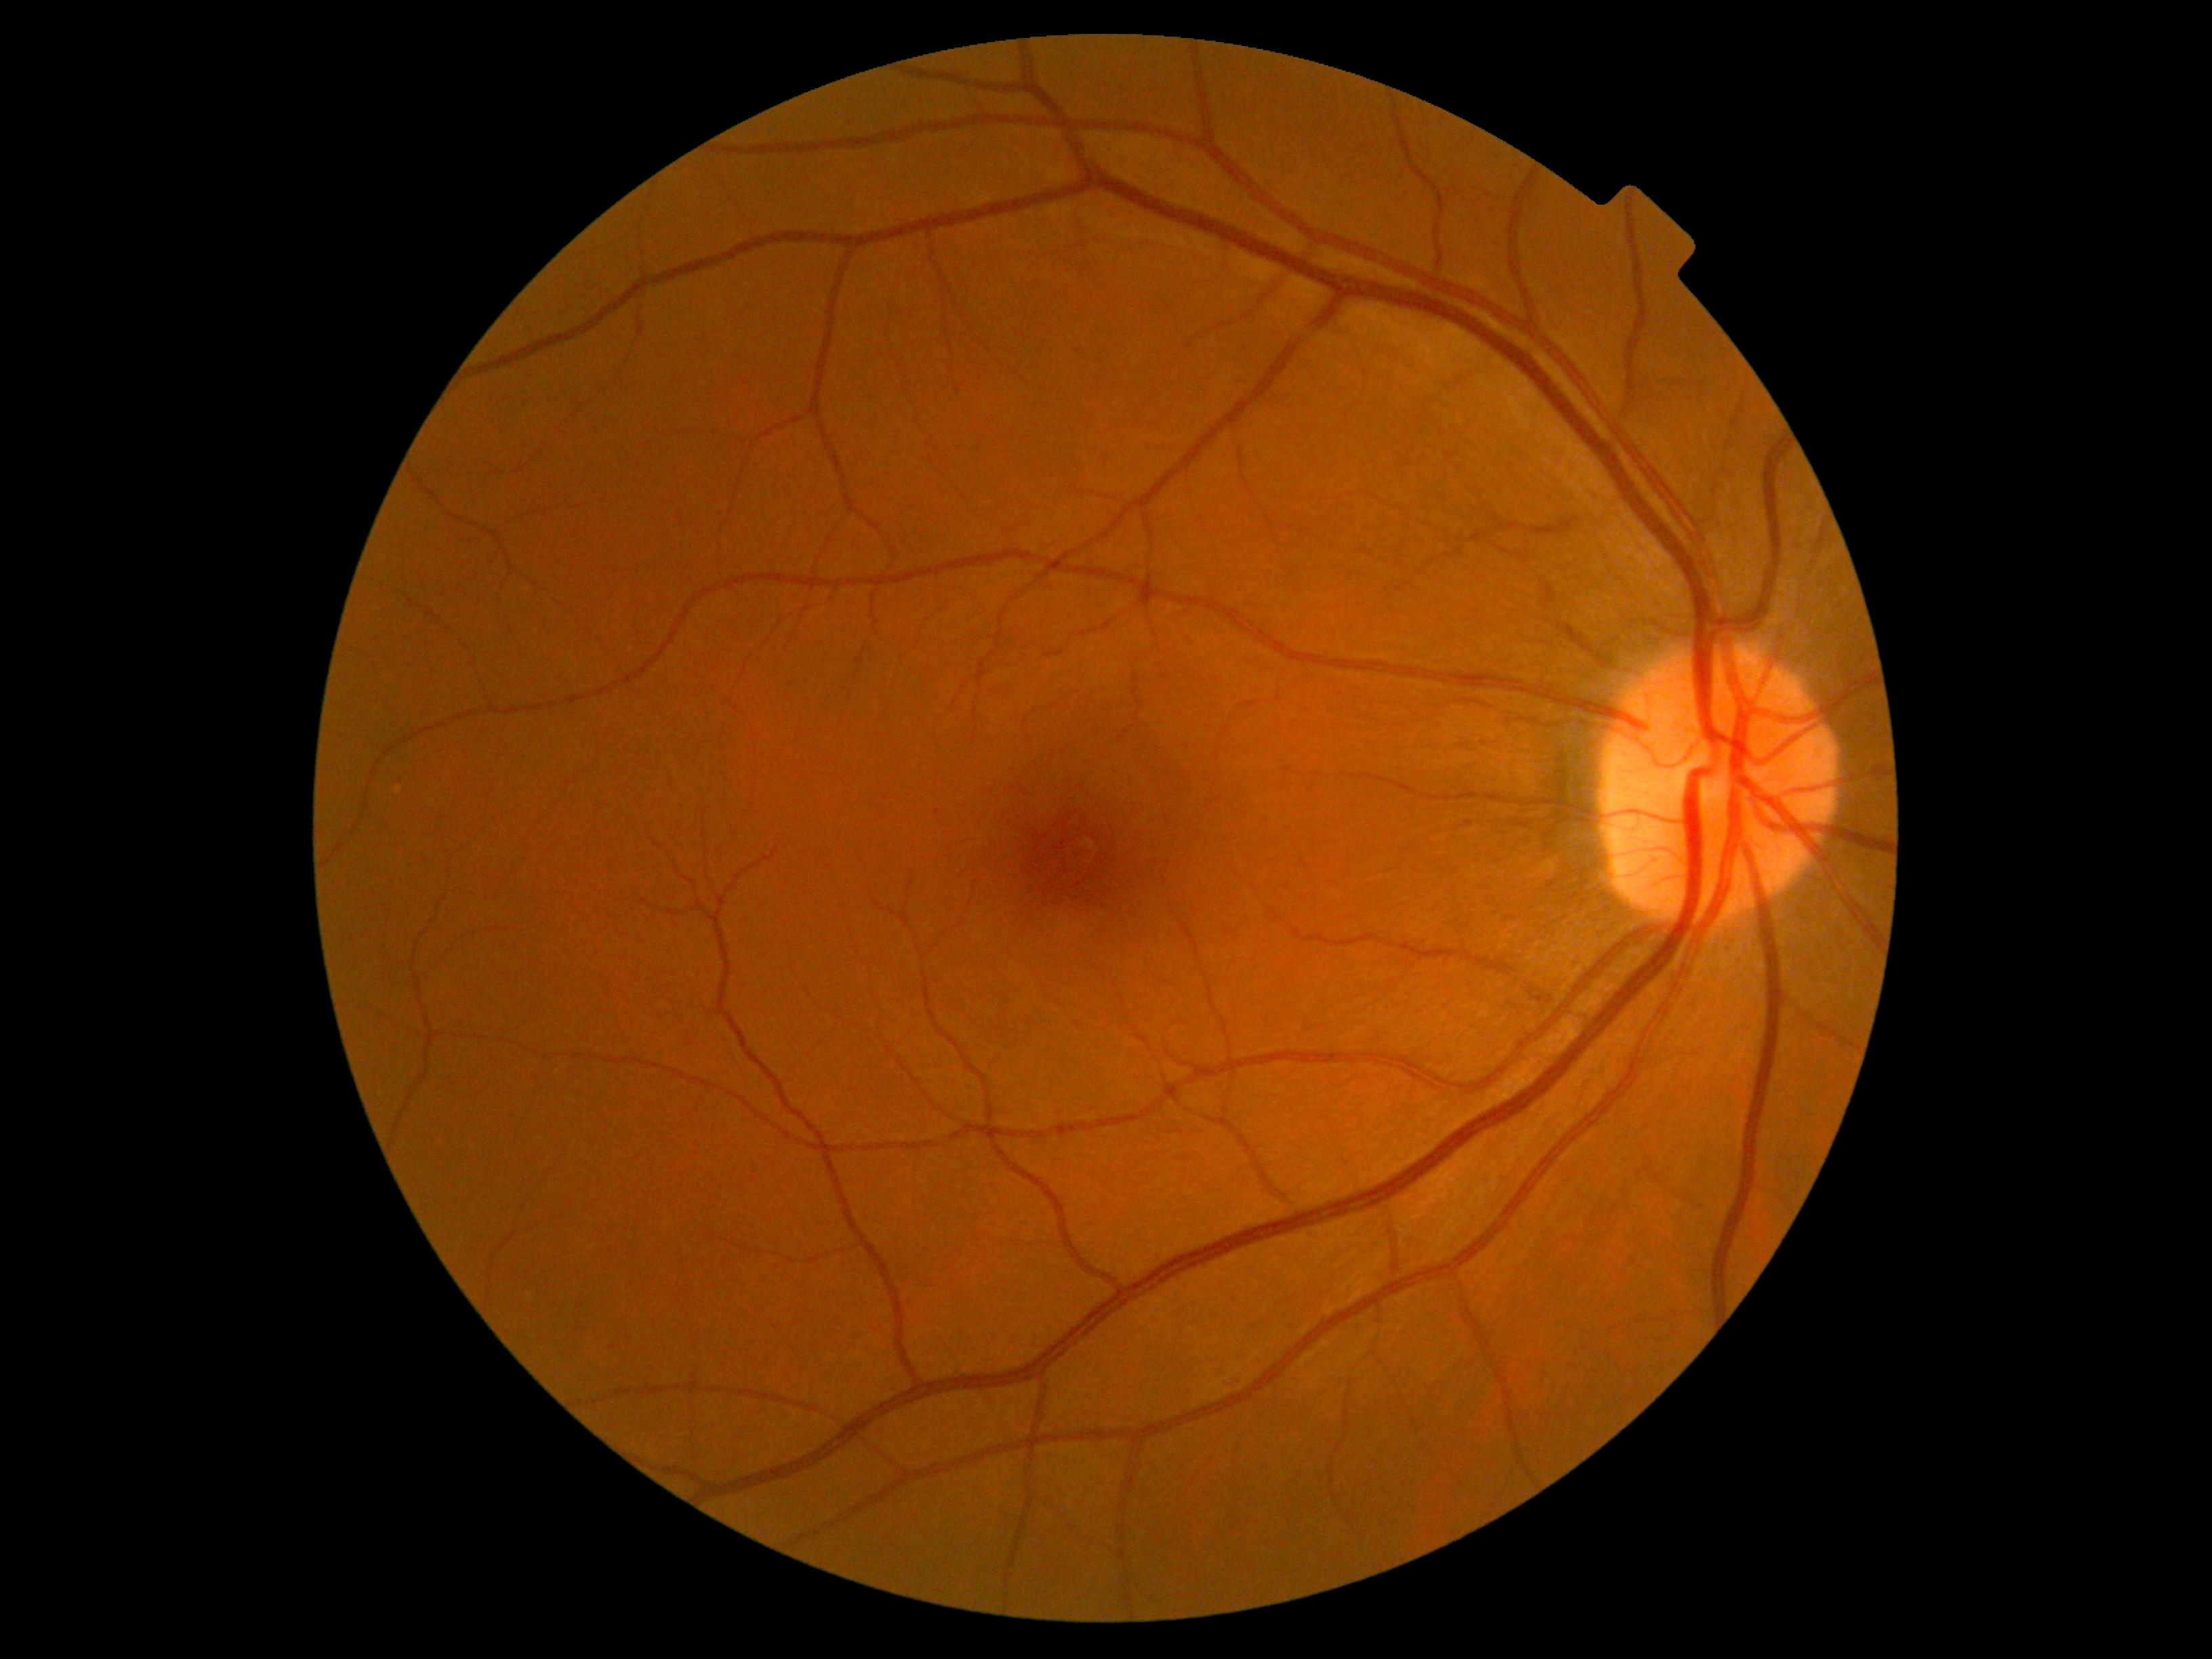 DR severity is grade 0 (no apparent retinopathy).